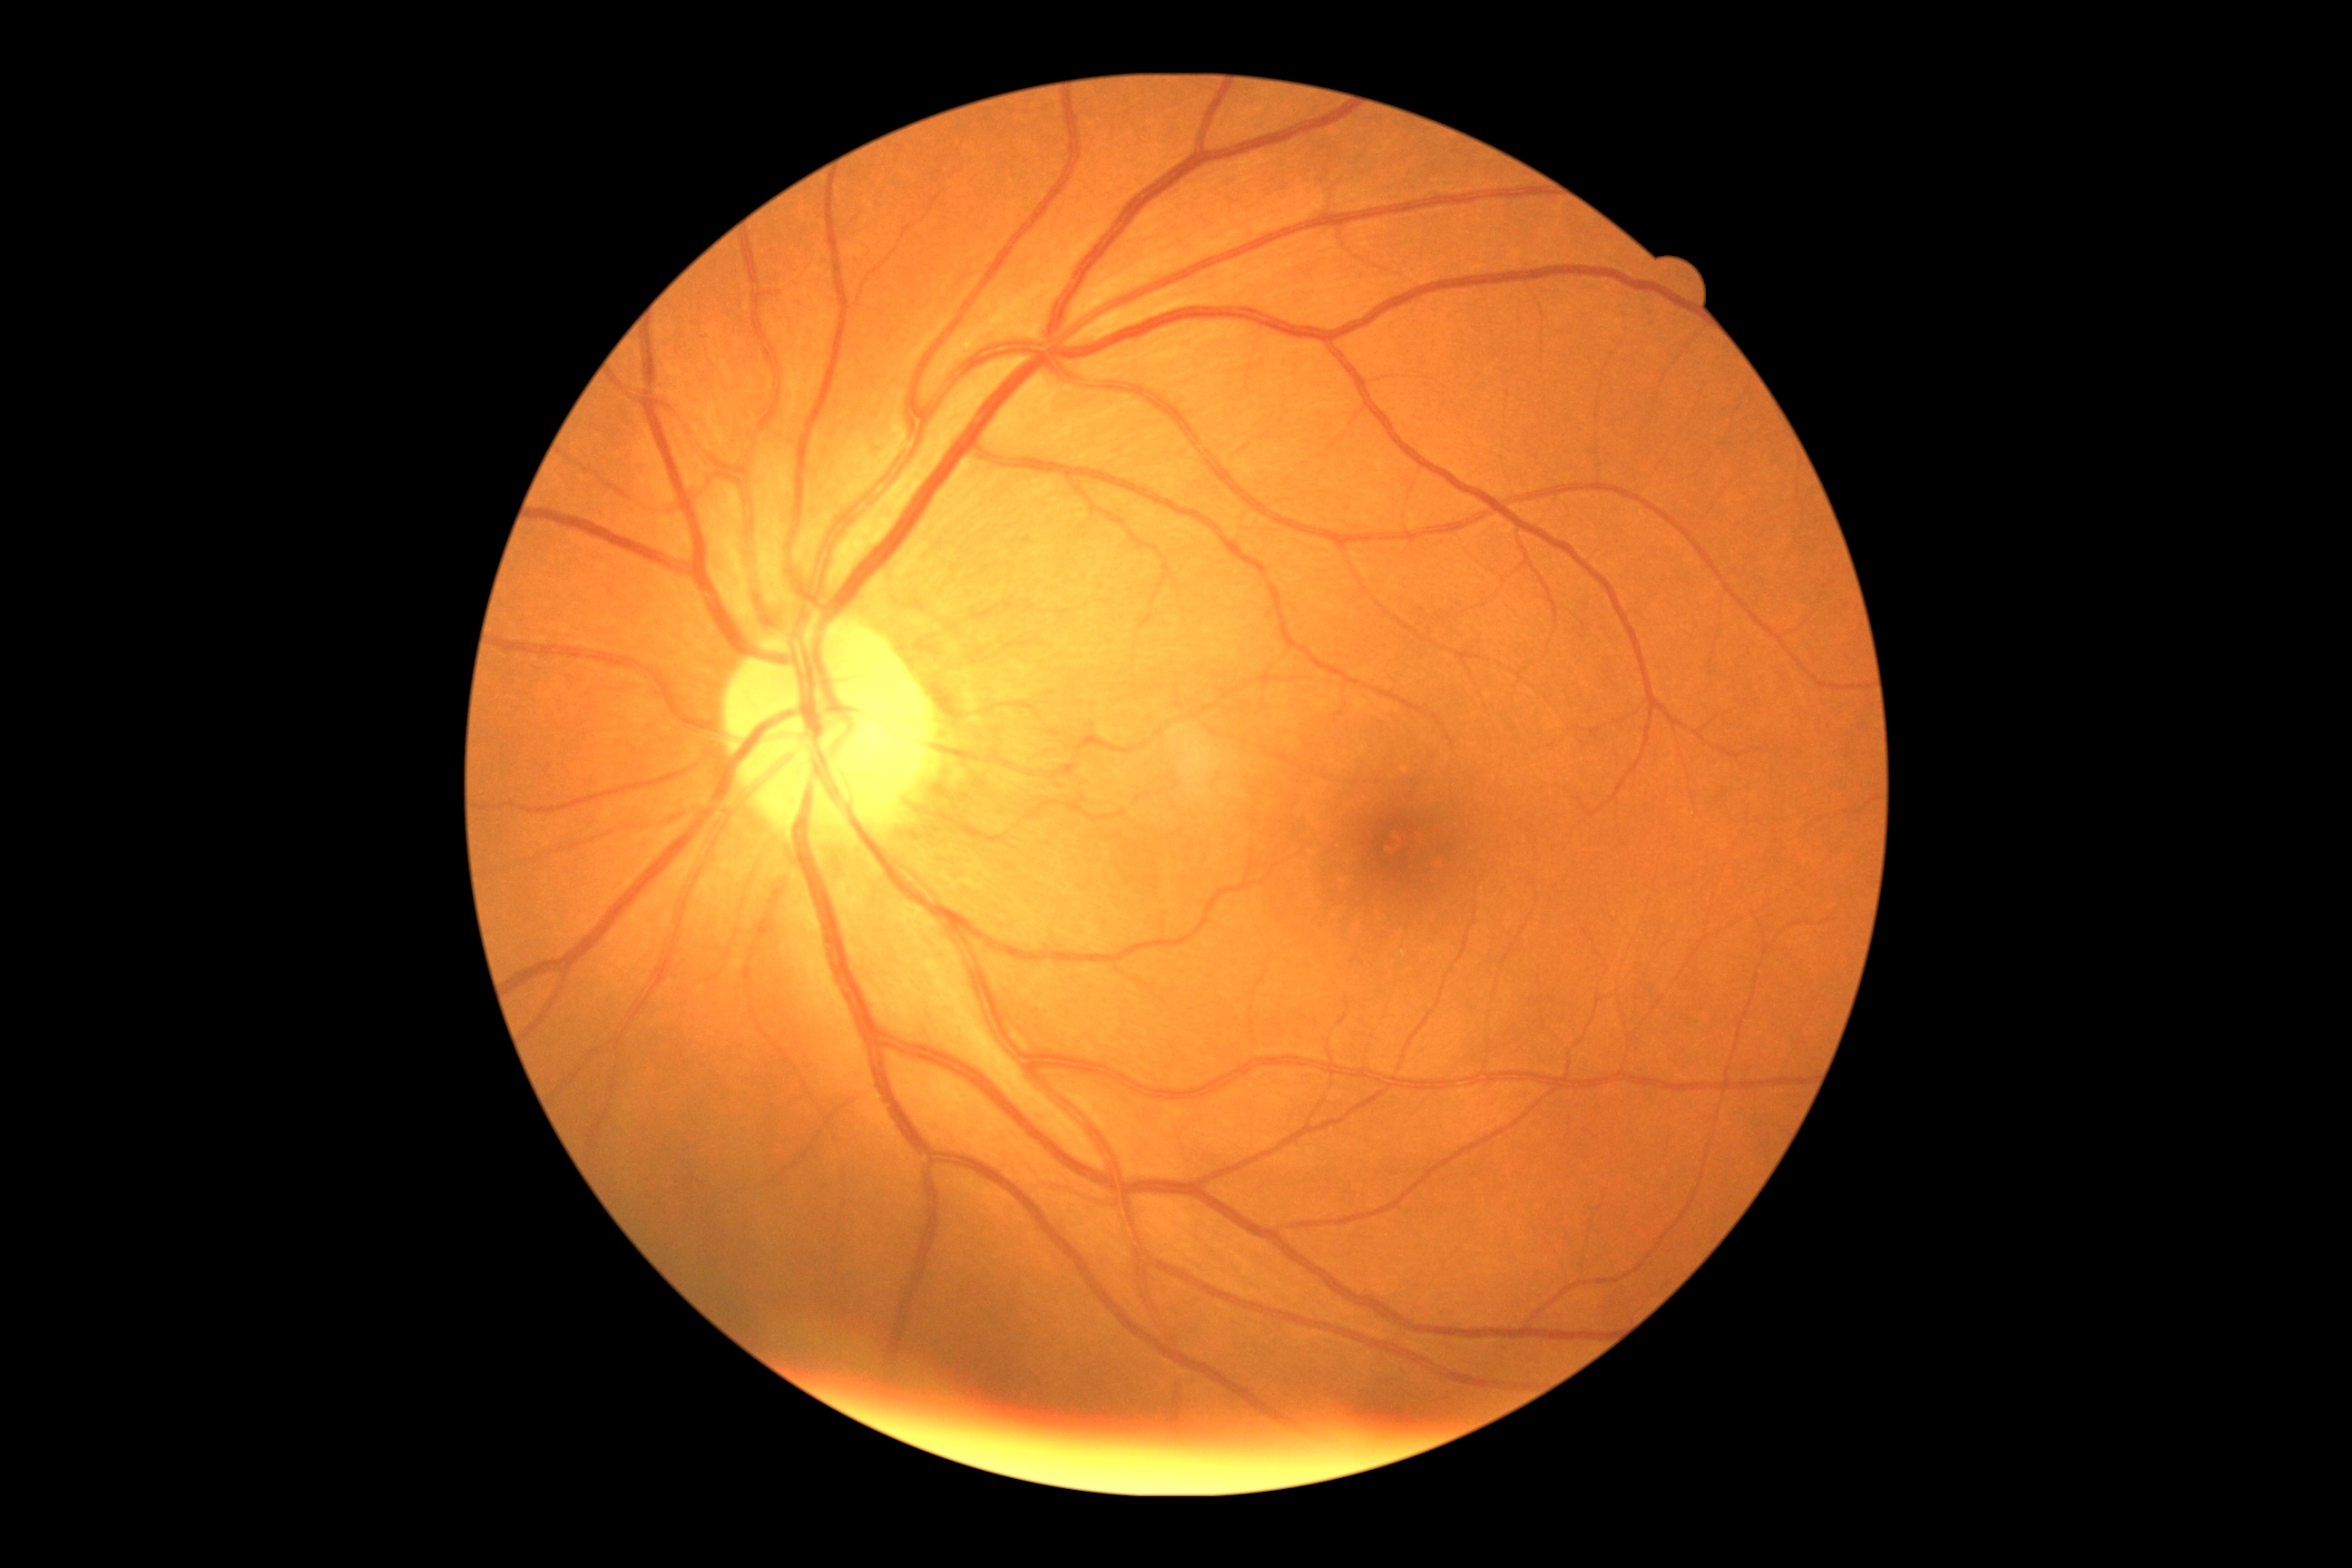

Annotations:
• diabetic retinopathy (DR) — grade 0 (no apparent retinopathy)